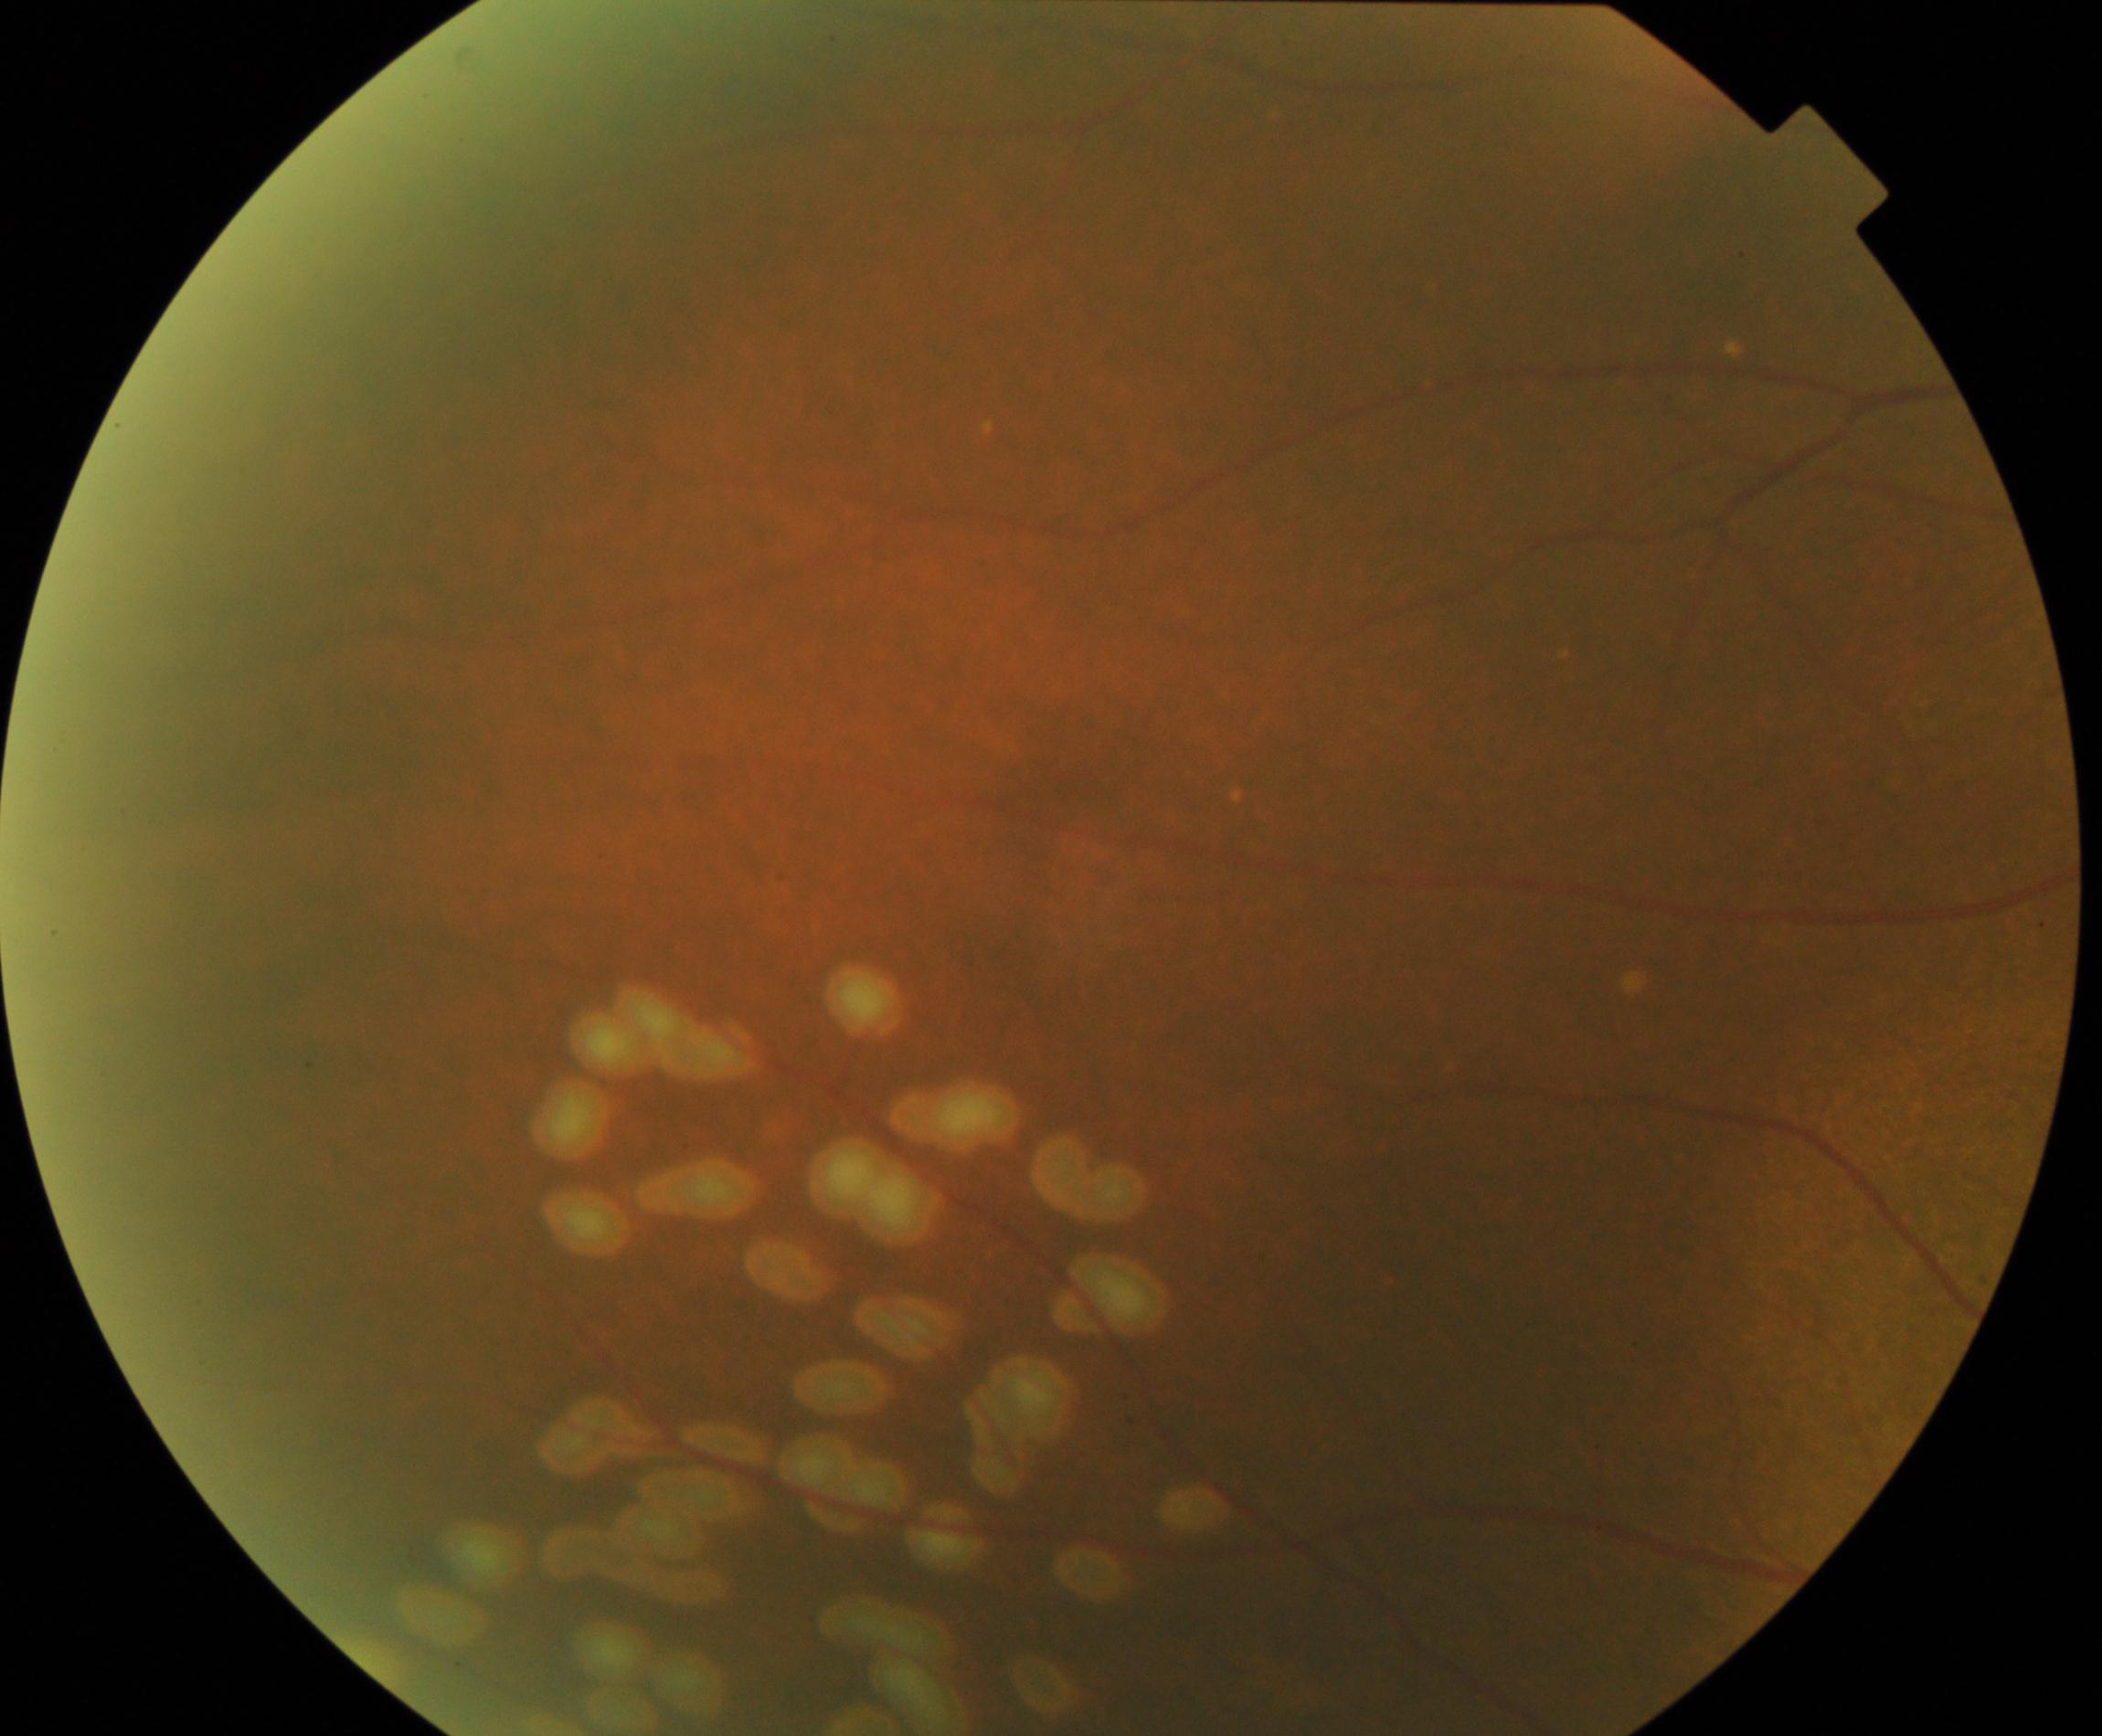

Impression: laser spots. Defined by multiple, uniform, round, discrete yellow-white or brown lesions from photocoagulation.